848x848.
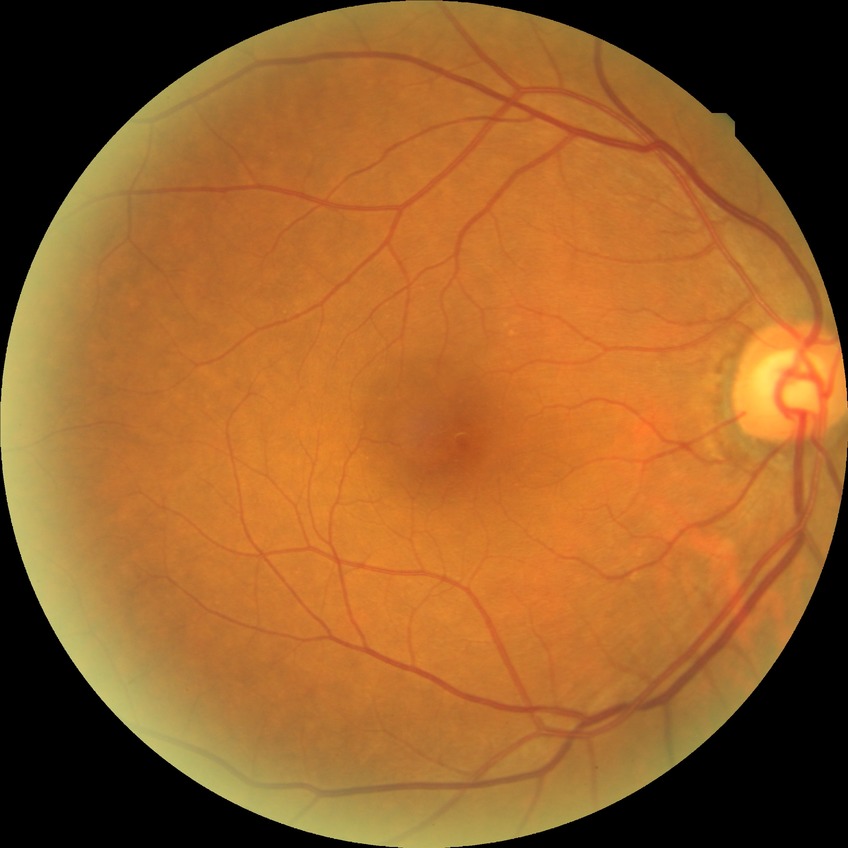 Assessment:
* modified Davis classification — no diabetic retinopathy